Wide-field fundus photograph of an infant · 640 x 480 pixels · Clarity RetCam 3, 130° FOV — 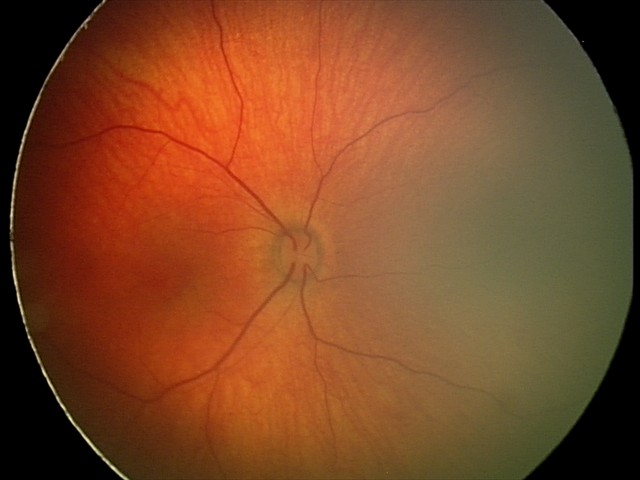
Series diagnosed as retinal hemorrhages.